Image size 640x480. Wide-field contact fundus photograph of an infant — 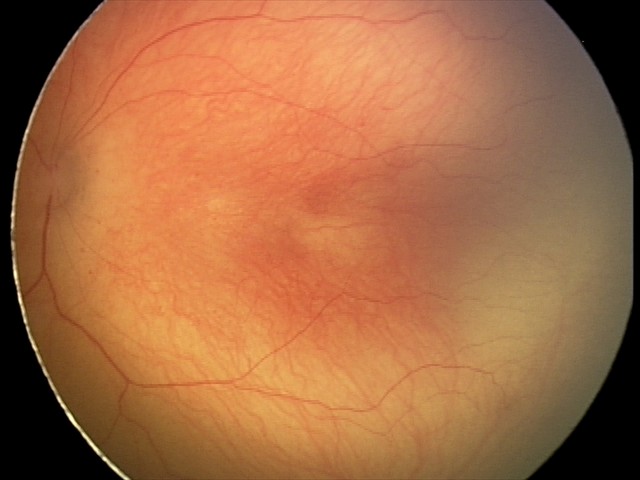

Without plus disease.
Series diagnosed as ROP stage 2.